1240 x 1240 pixels · camera: Phoenix ICON (100° FOV) · Phoenix ICON wide-field infant fundus image: 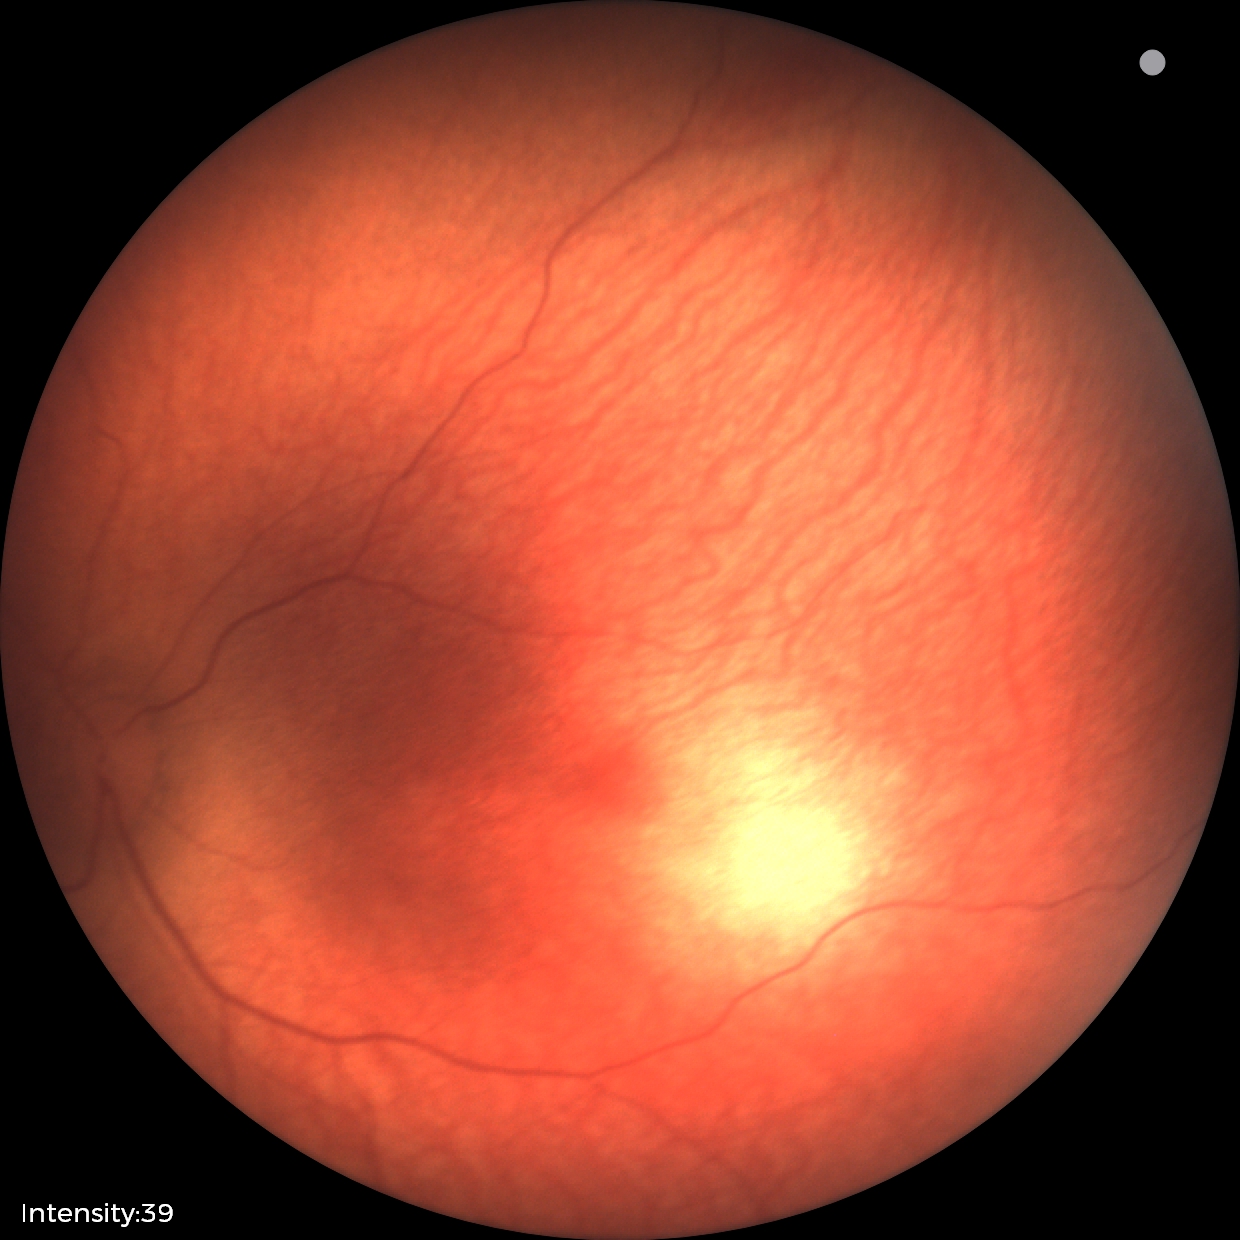 Screening diagnosis: no abnormal retinal findings.